45° field of view · image size 2352x1568: 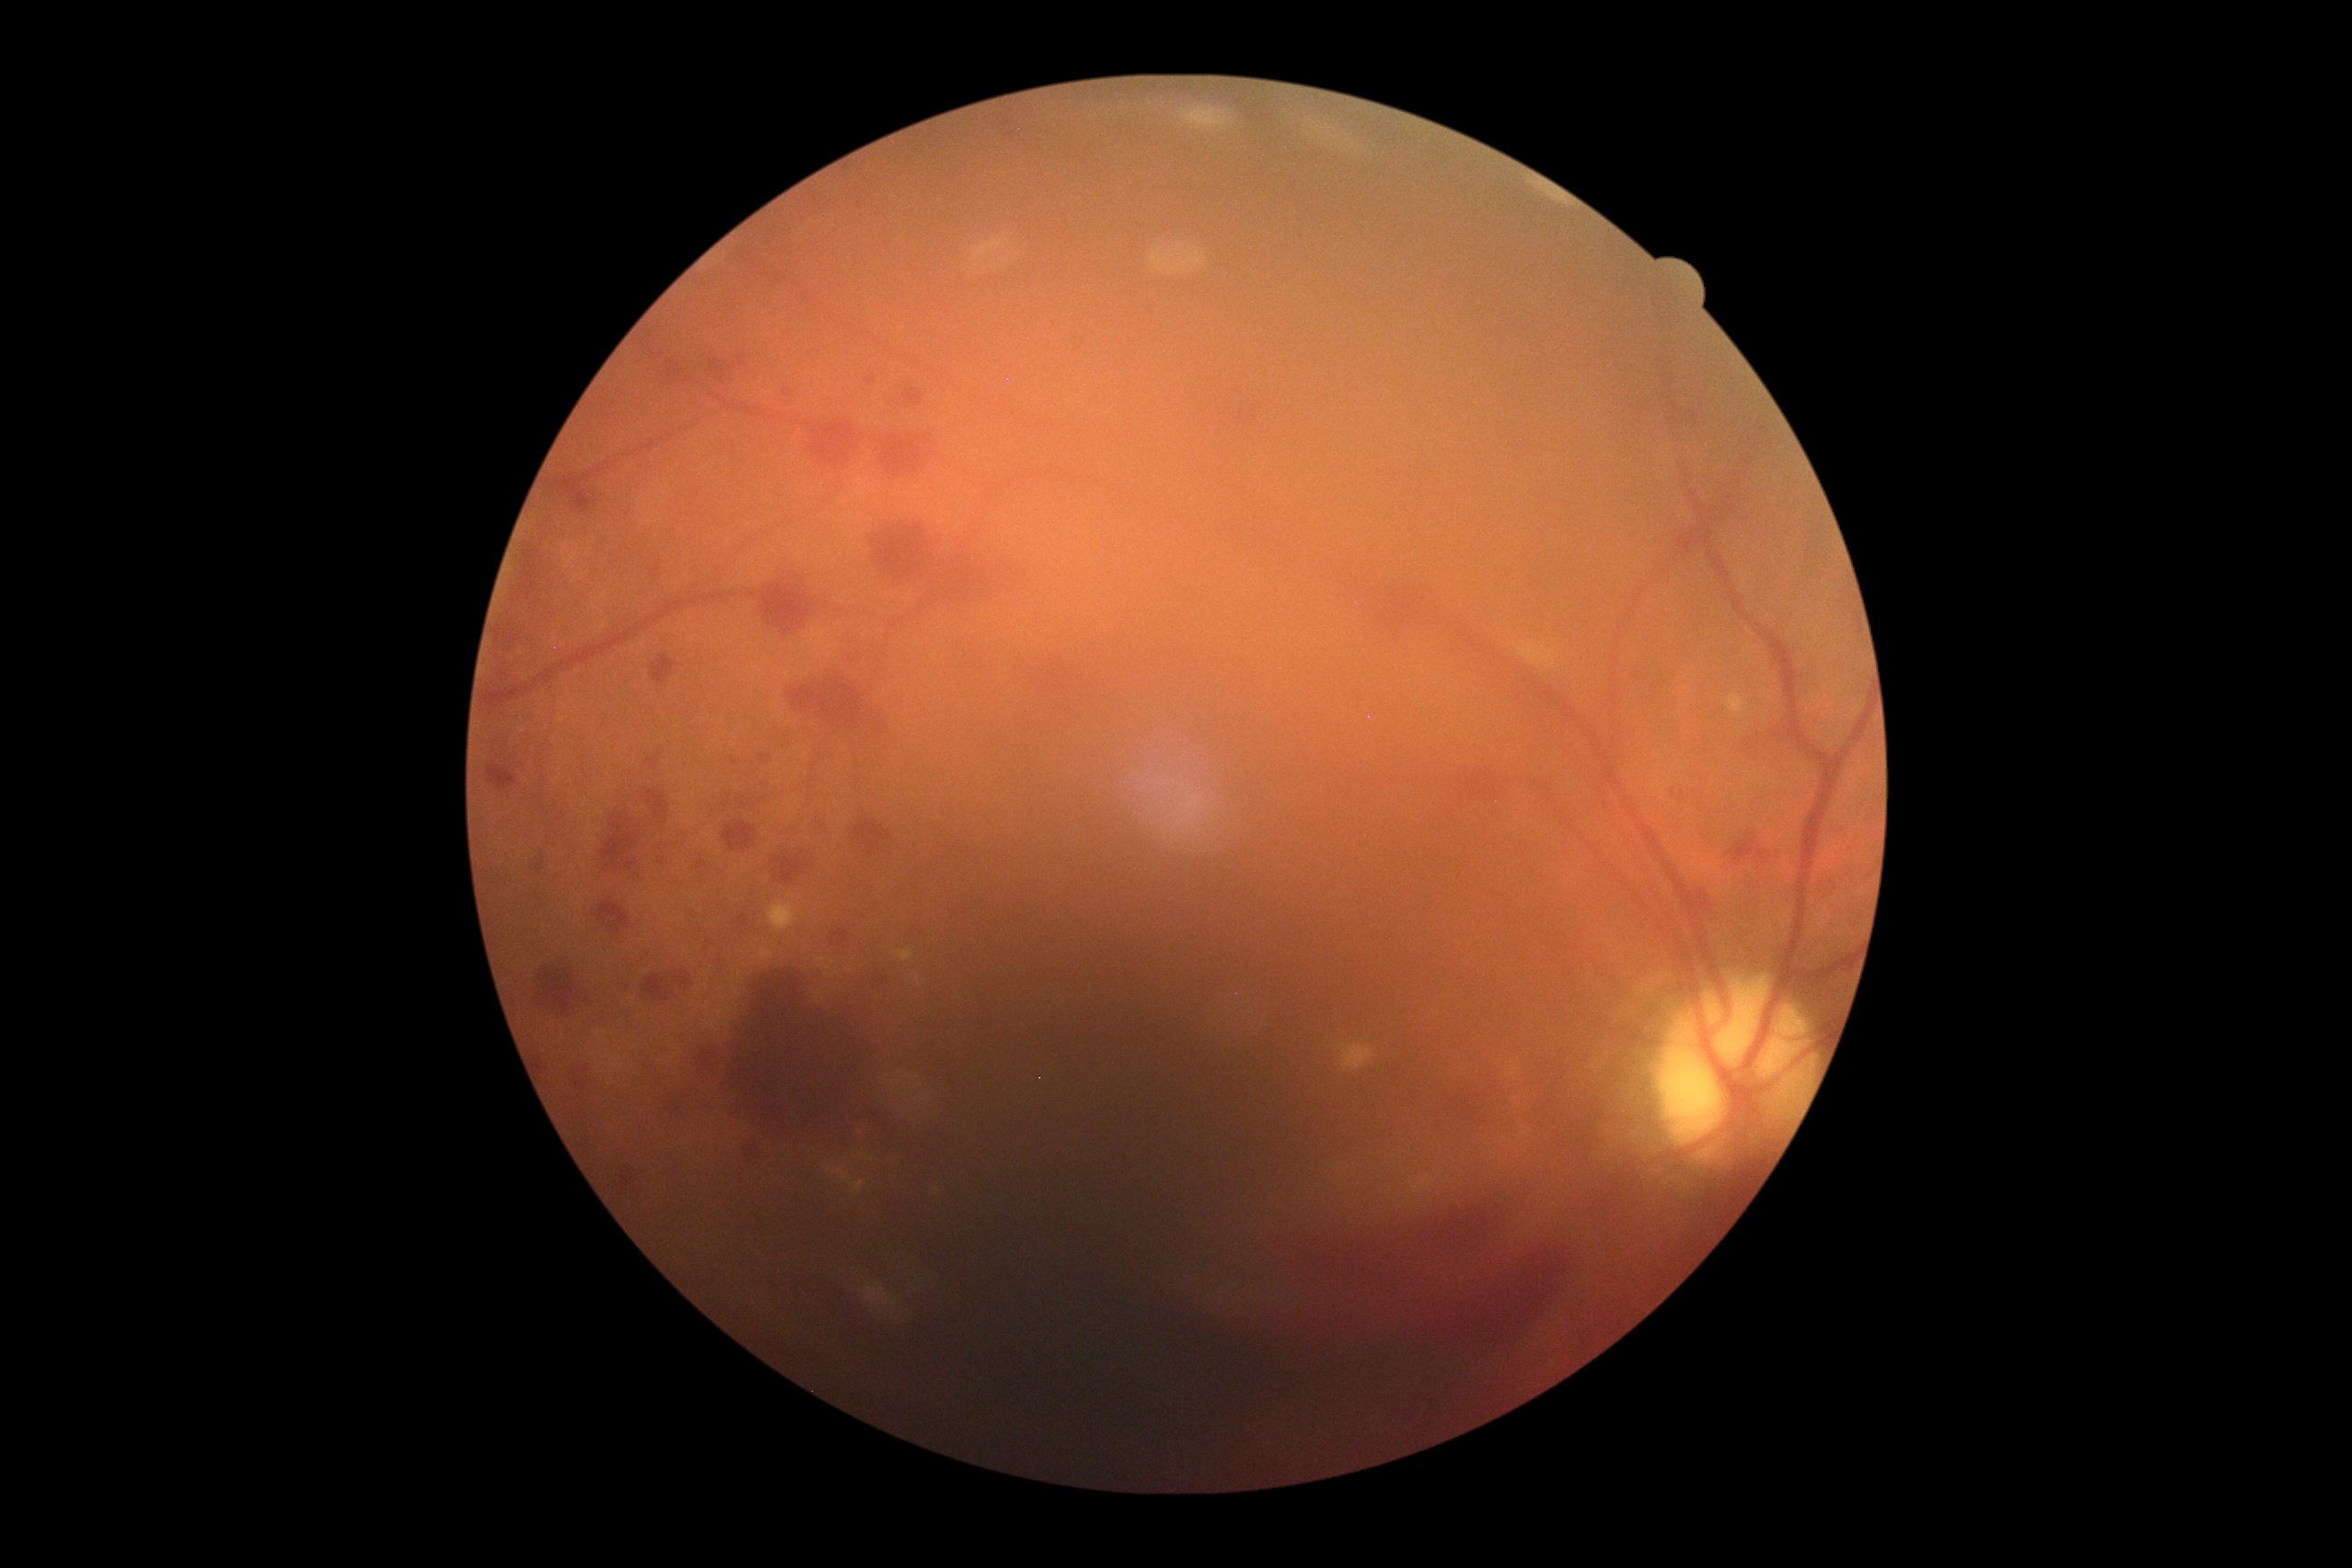

DR grade is 4.